1240x1240; Phoenix ICON, 100° FOV; pediatric wide-field fundus photograph:
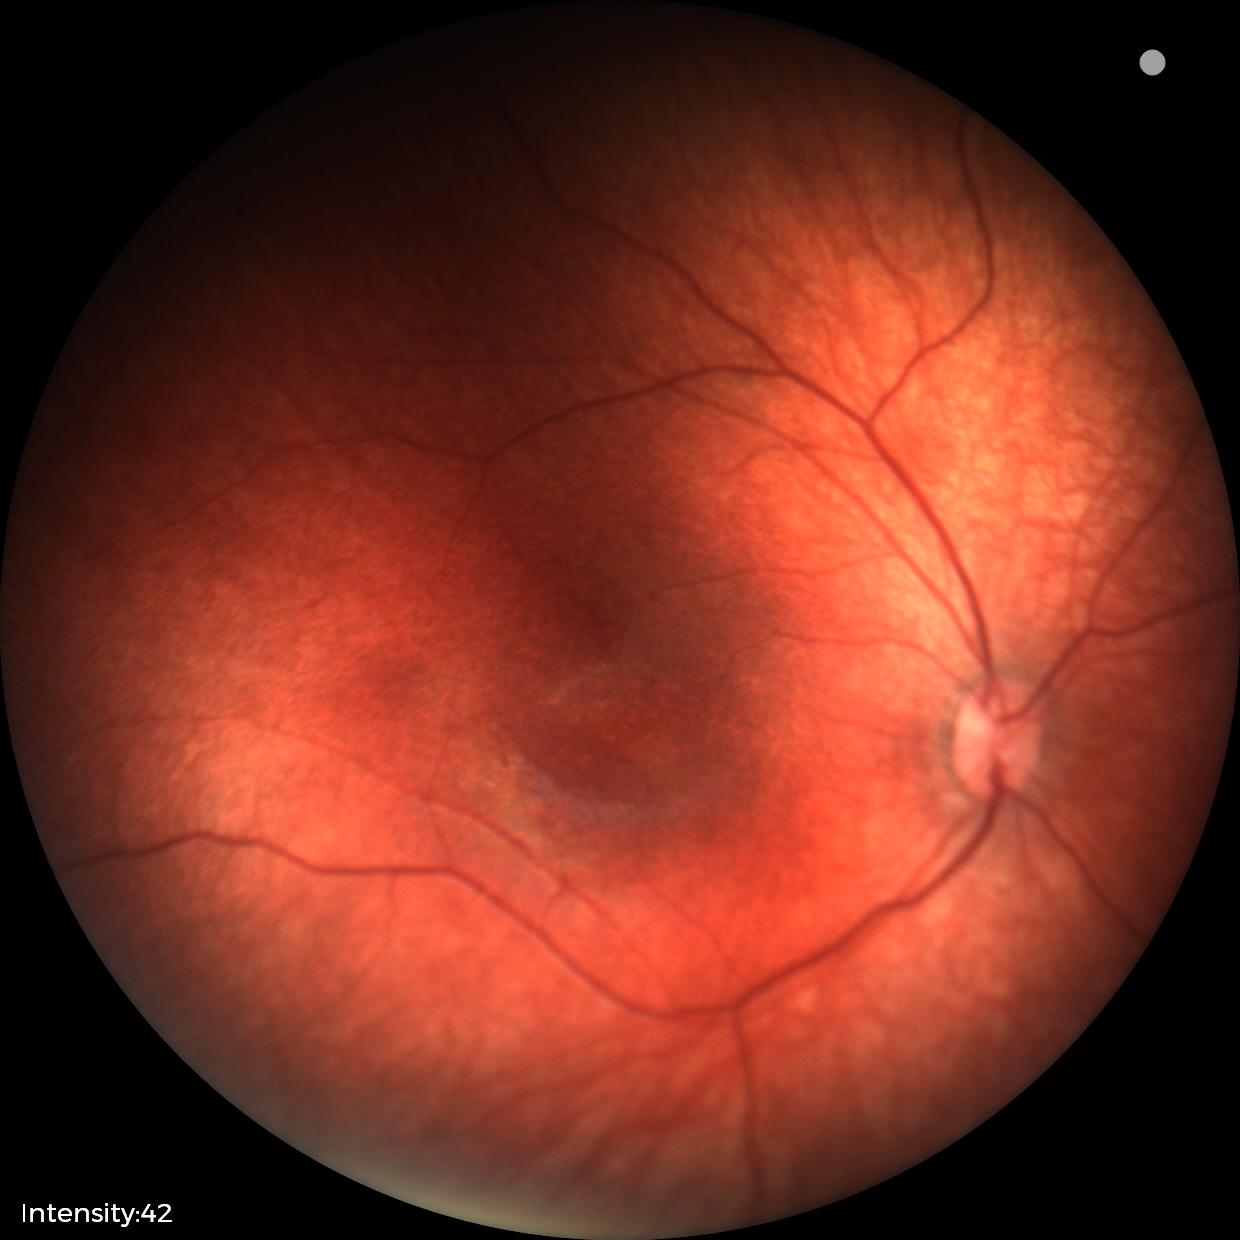

Physiological retinal appearance for postconceptual age.